Retinal fundus photograph: 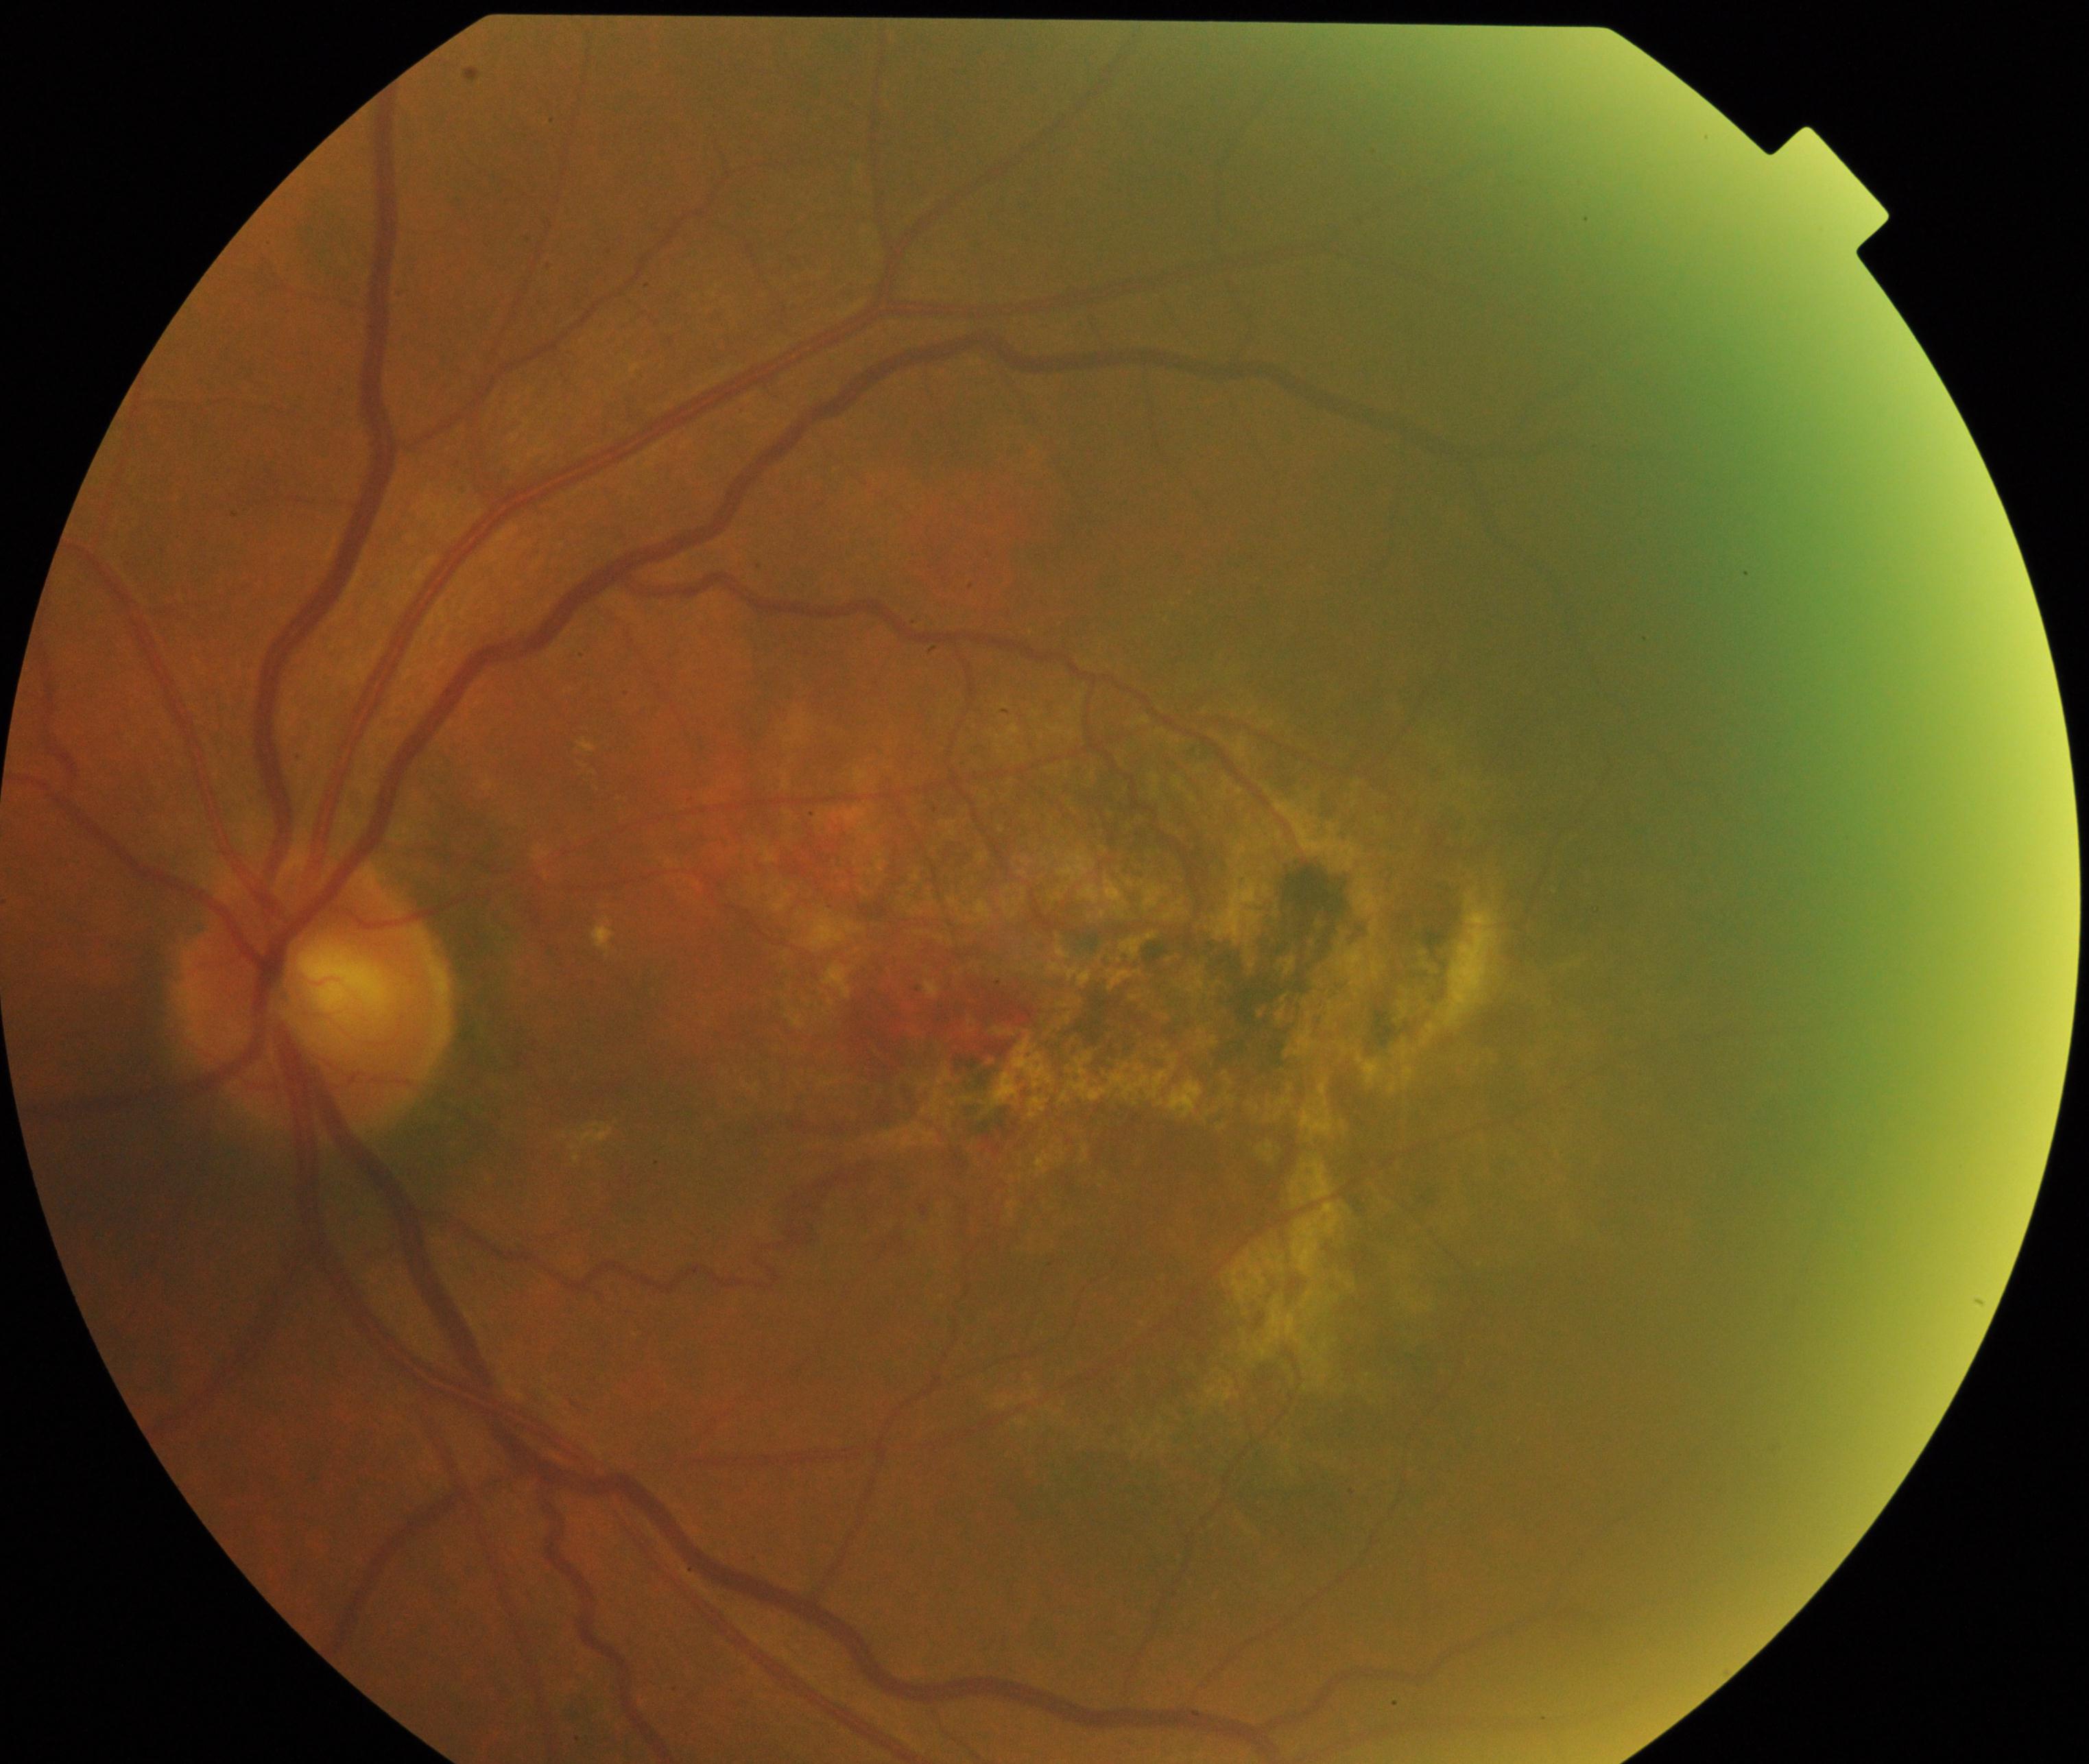
Classification: maculopathy.